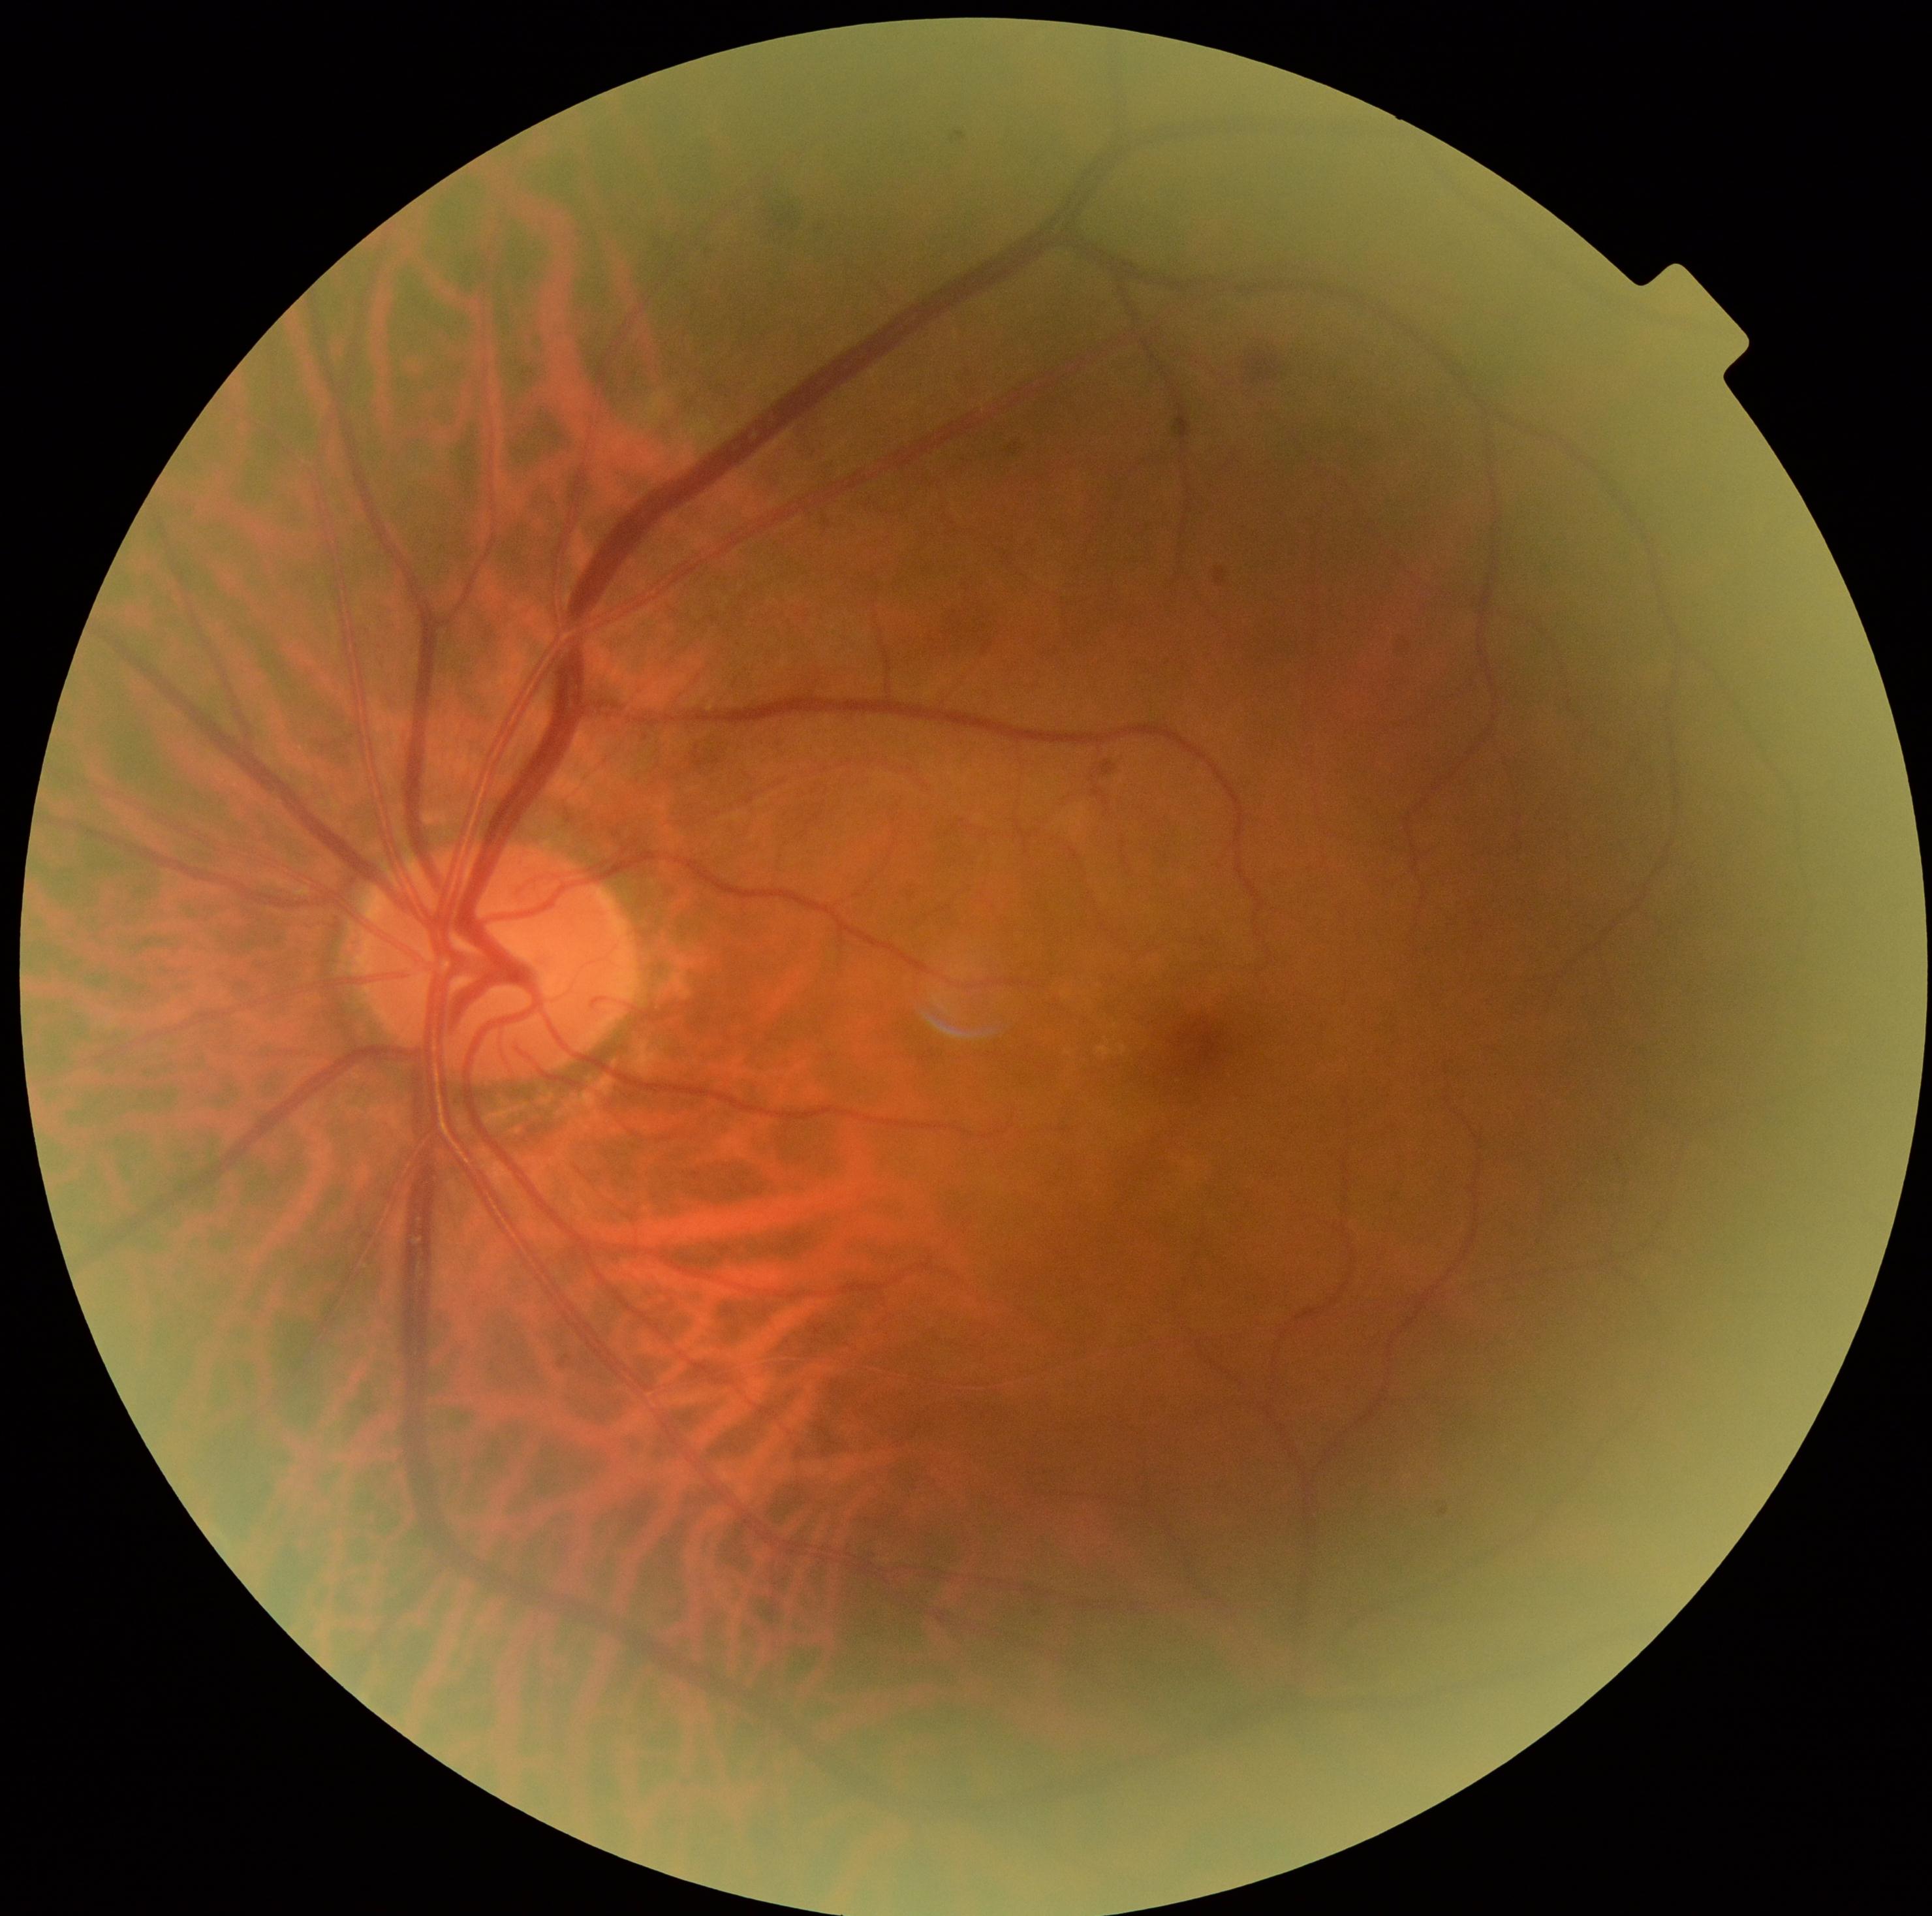
{
  "dr_category": "non-proliferative diabetic retinopathy",
  "dr_grade": "moderate NPDR (grade 2)"
}